CFP. 2352 by 1568 pixels — 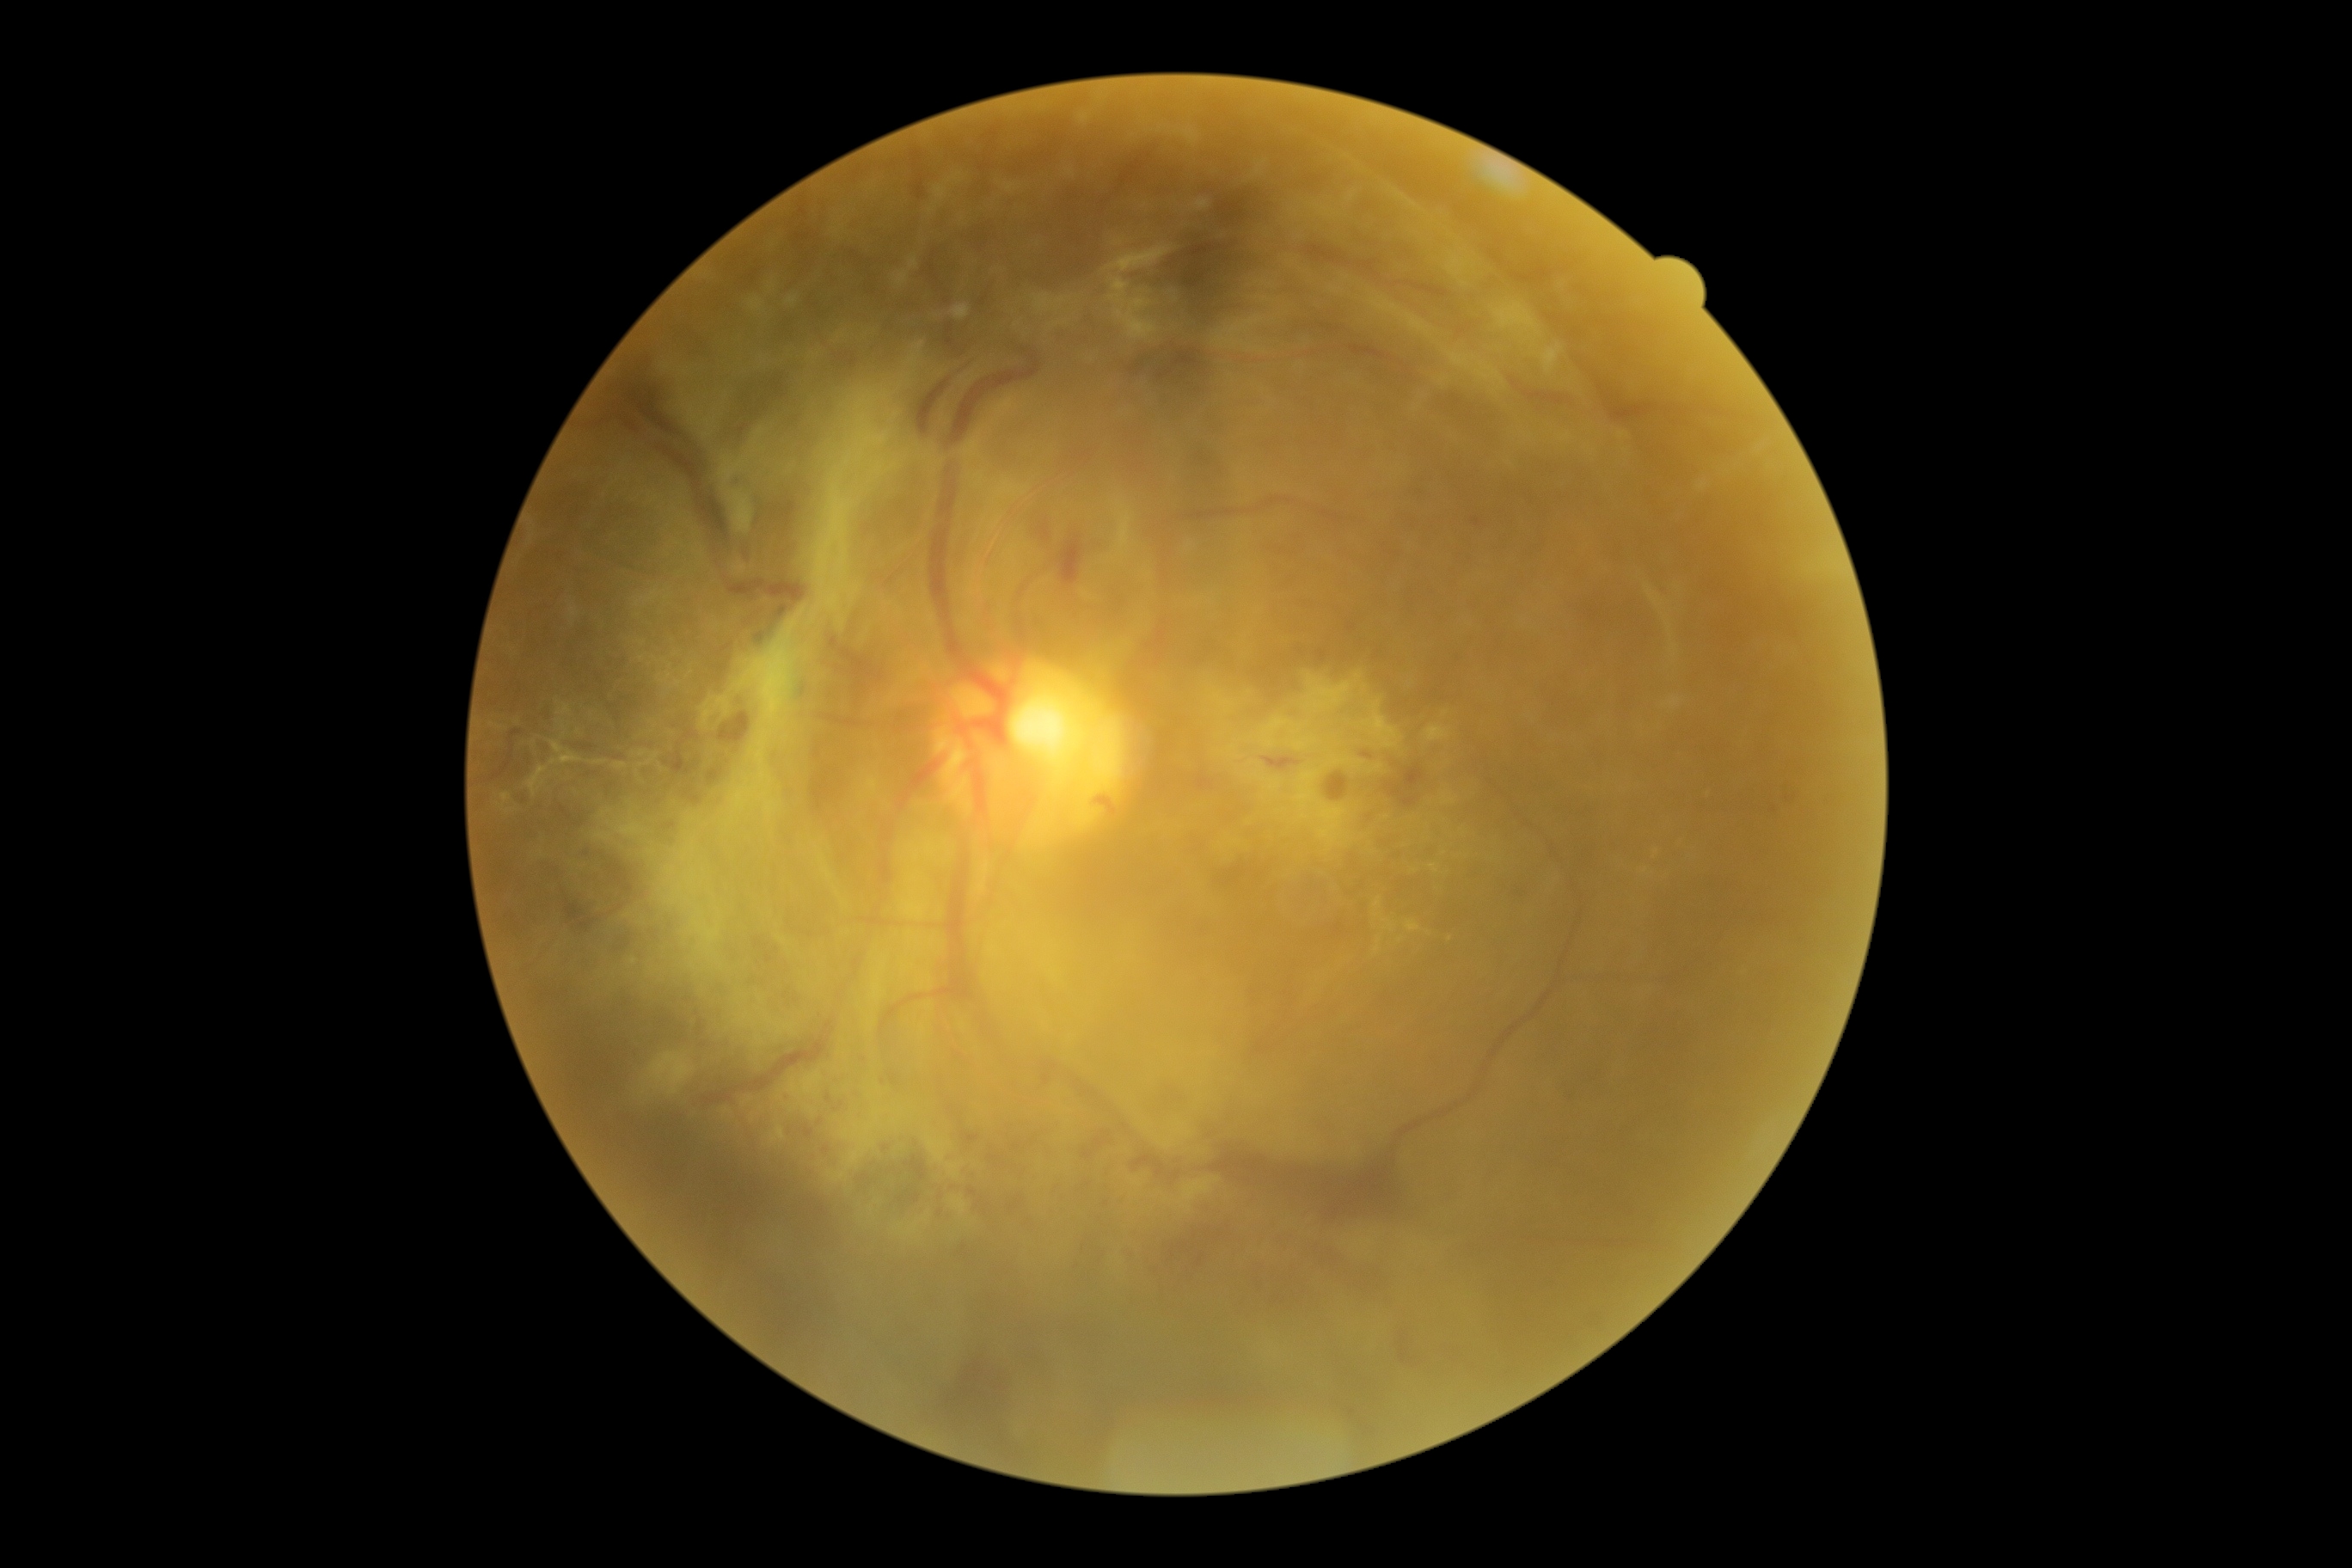   dr_grade: 4/4
  dr_category: proliferative diabetic retinopathy